Remidio Fundus on Phone (FOP) camera · image size 1659x2212
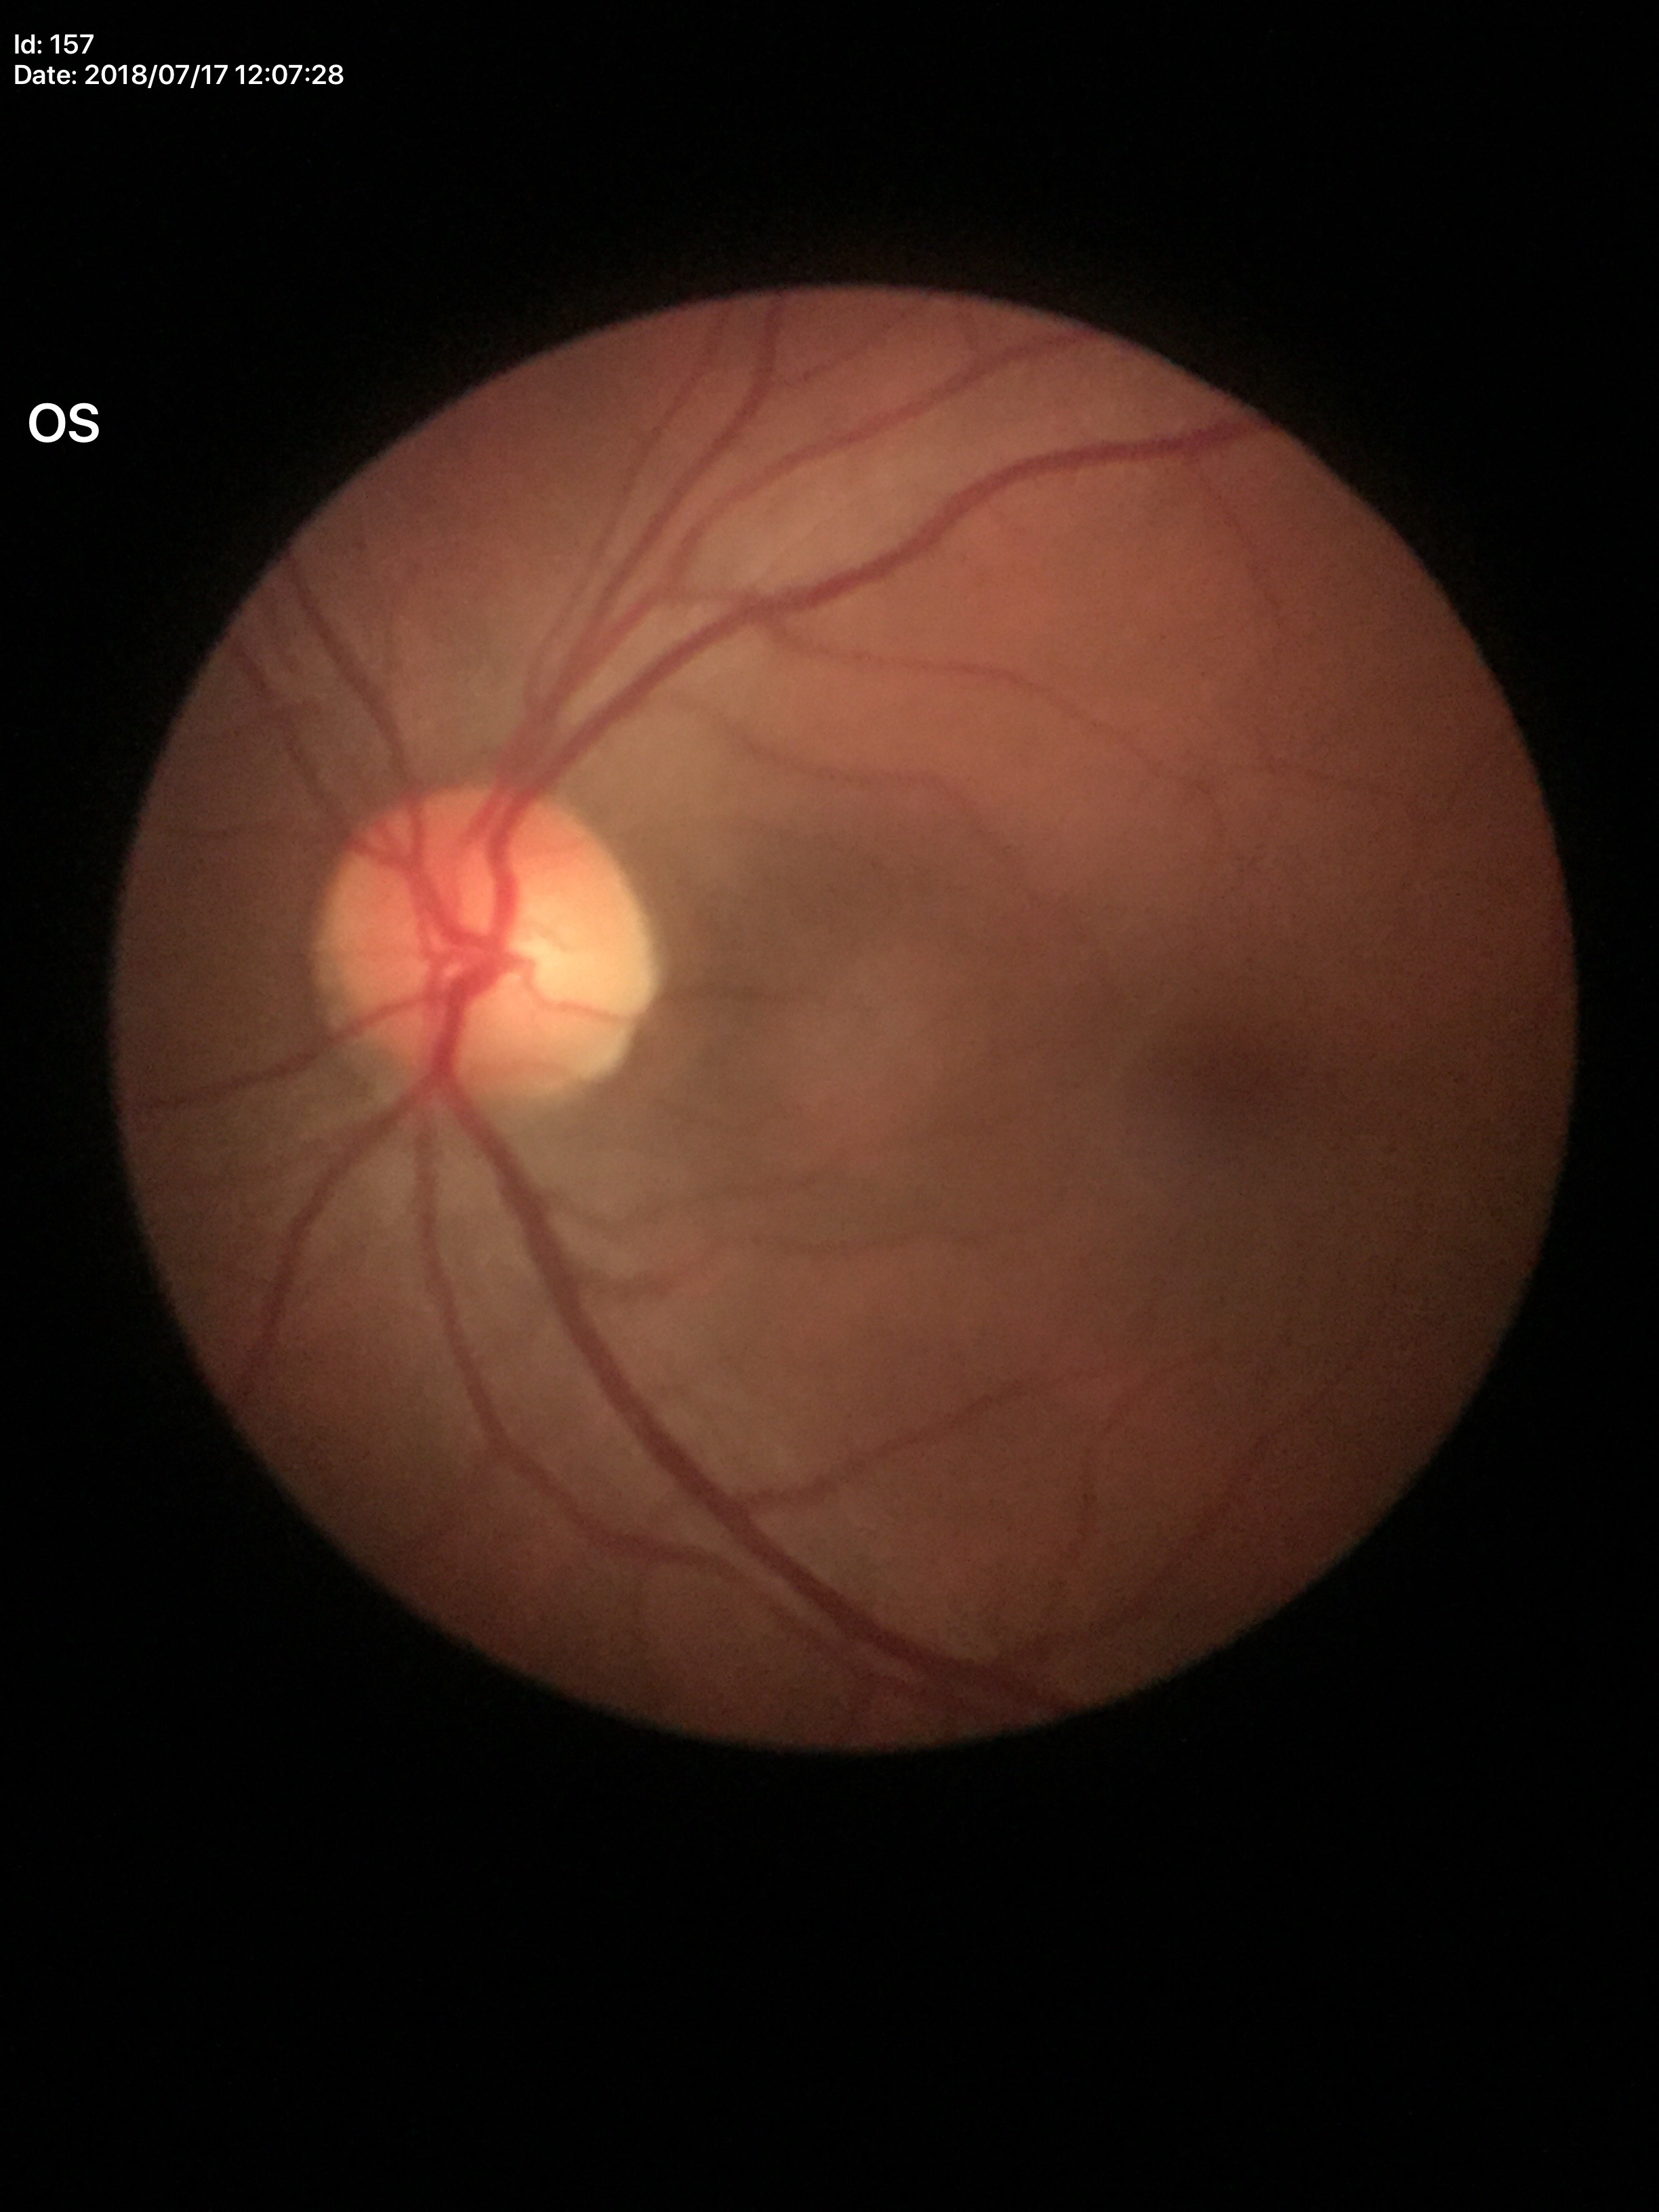
Glaucoma screening = not suspect; vertical cup-to-disc ratio (VCDR) = 0.45.